Acquired with a NIDEK AFC-230 · no pharmacologic dilation:
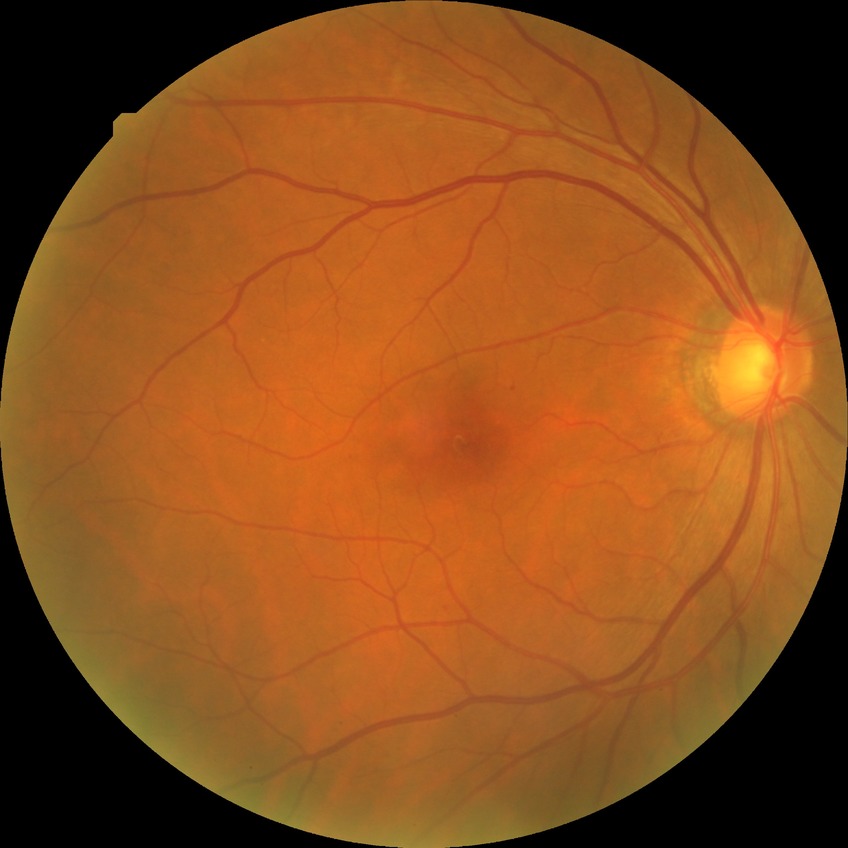

{
  "davis_grade": "simple diabetic retinopathy"
}